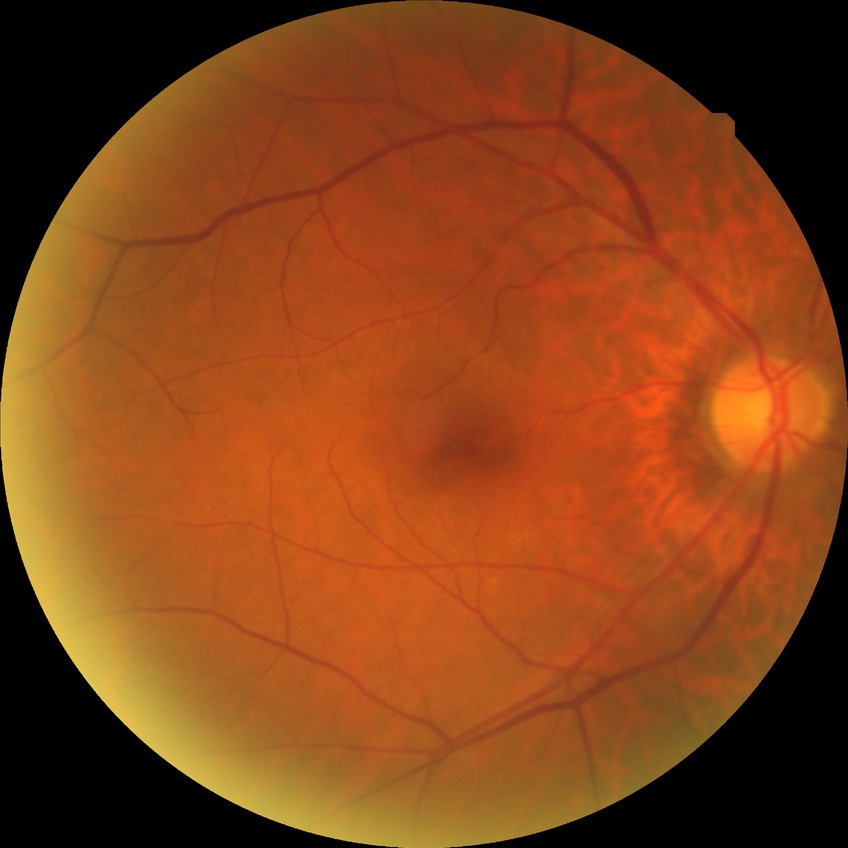
Annotations:
– Davis grading: no diabetic retinopathy